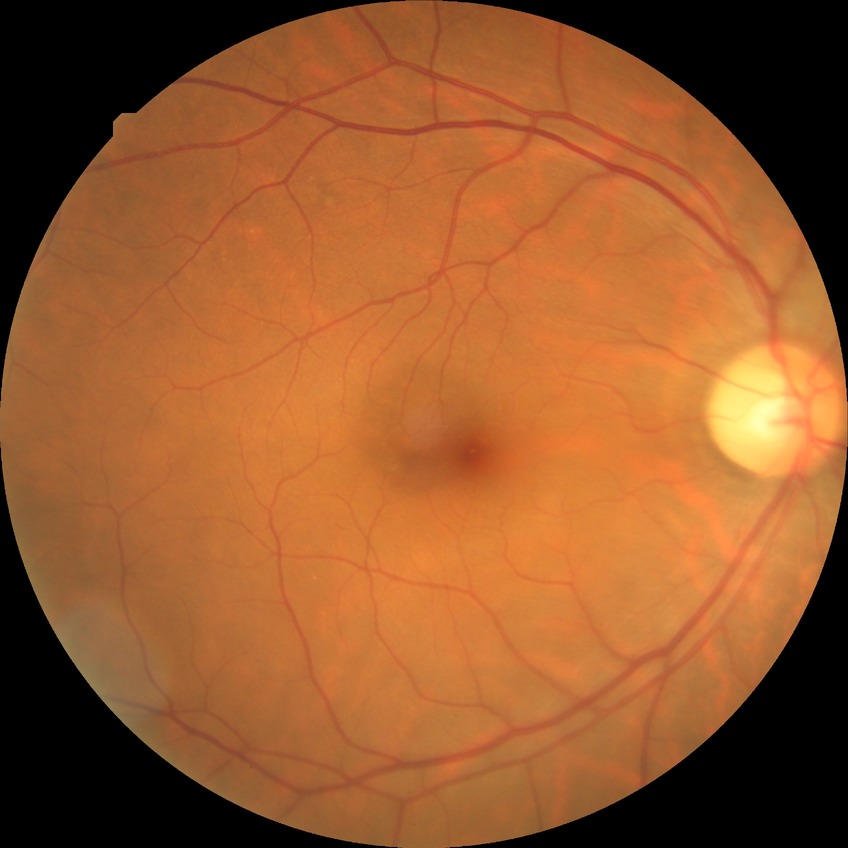
Davis stage=NDR; DR impression=no signs of DR.